Retinal fundus photograph — 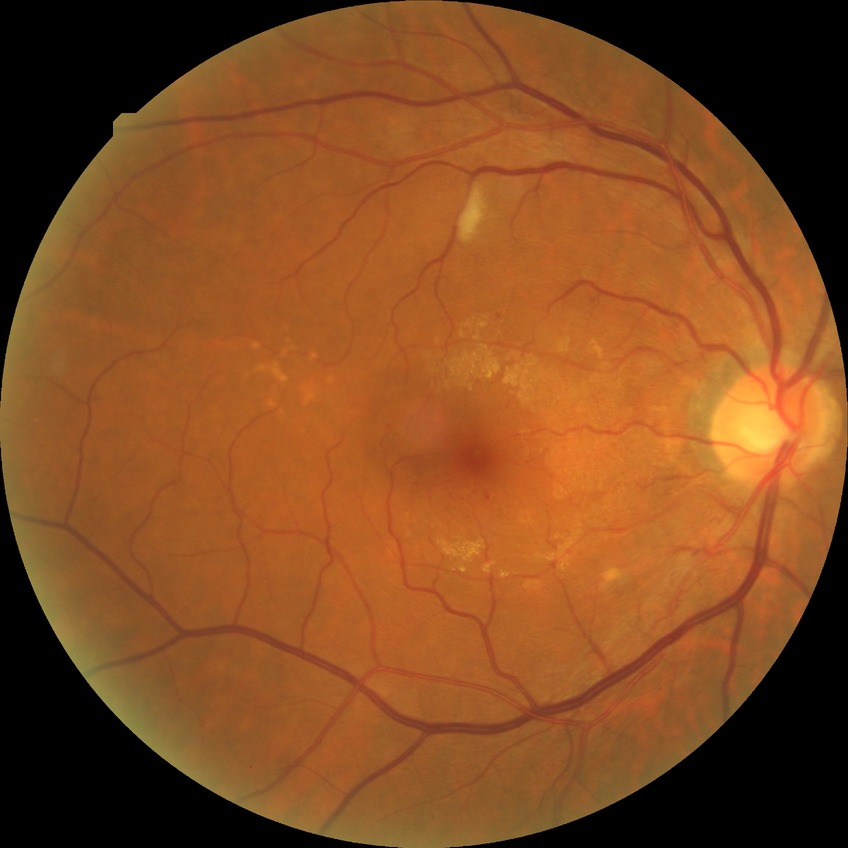
Retinopathy stage is pre-proliferative diabetic retinopathy.